Image size 2346x1568. Retinal fundus photograph.
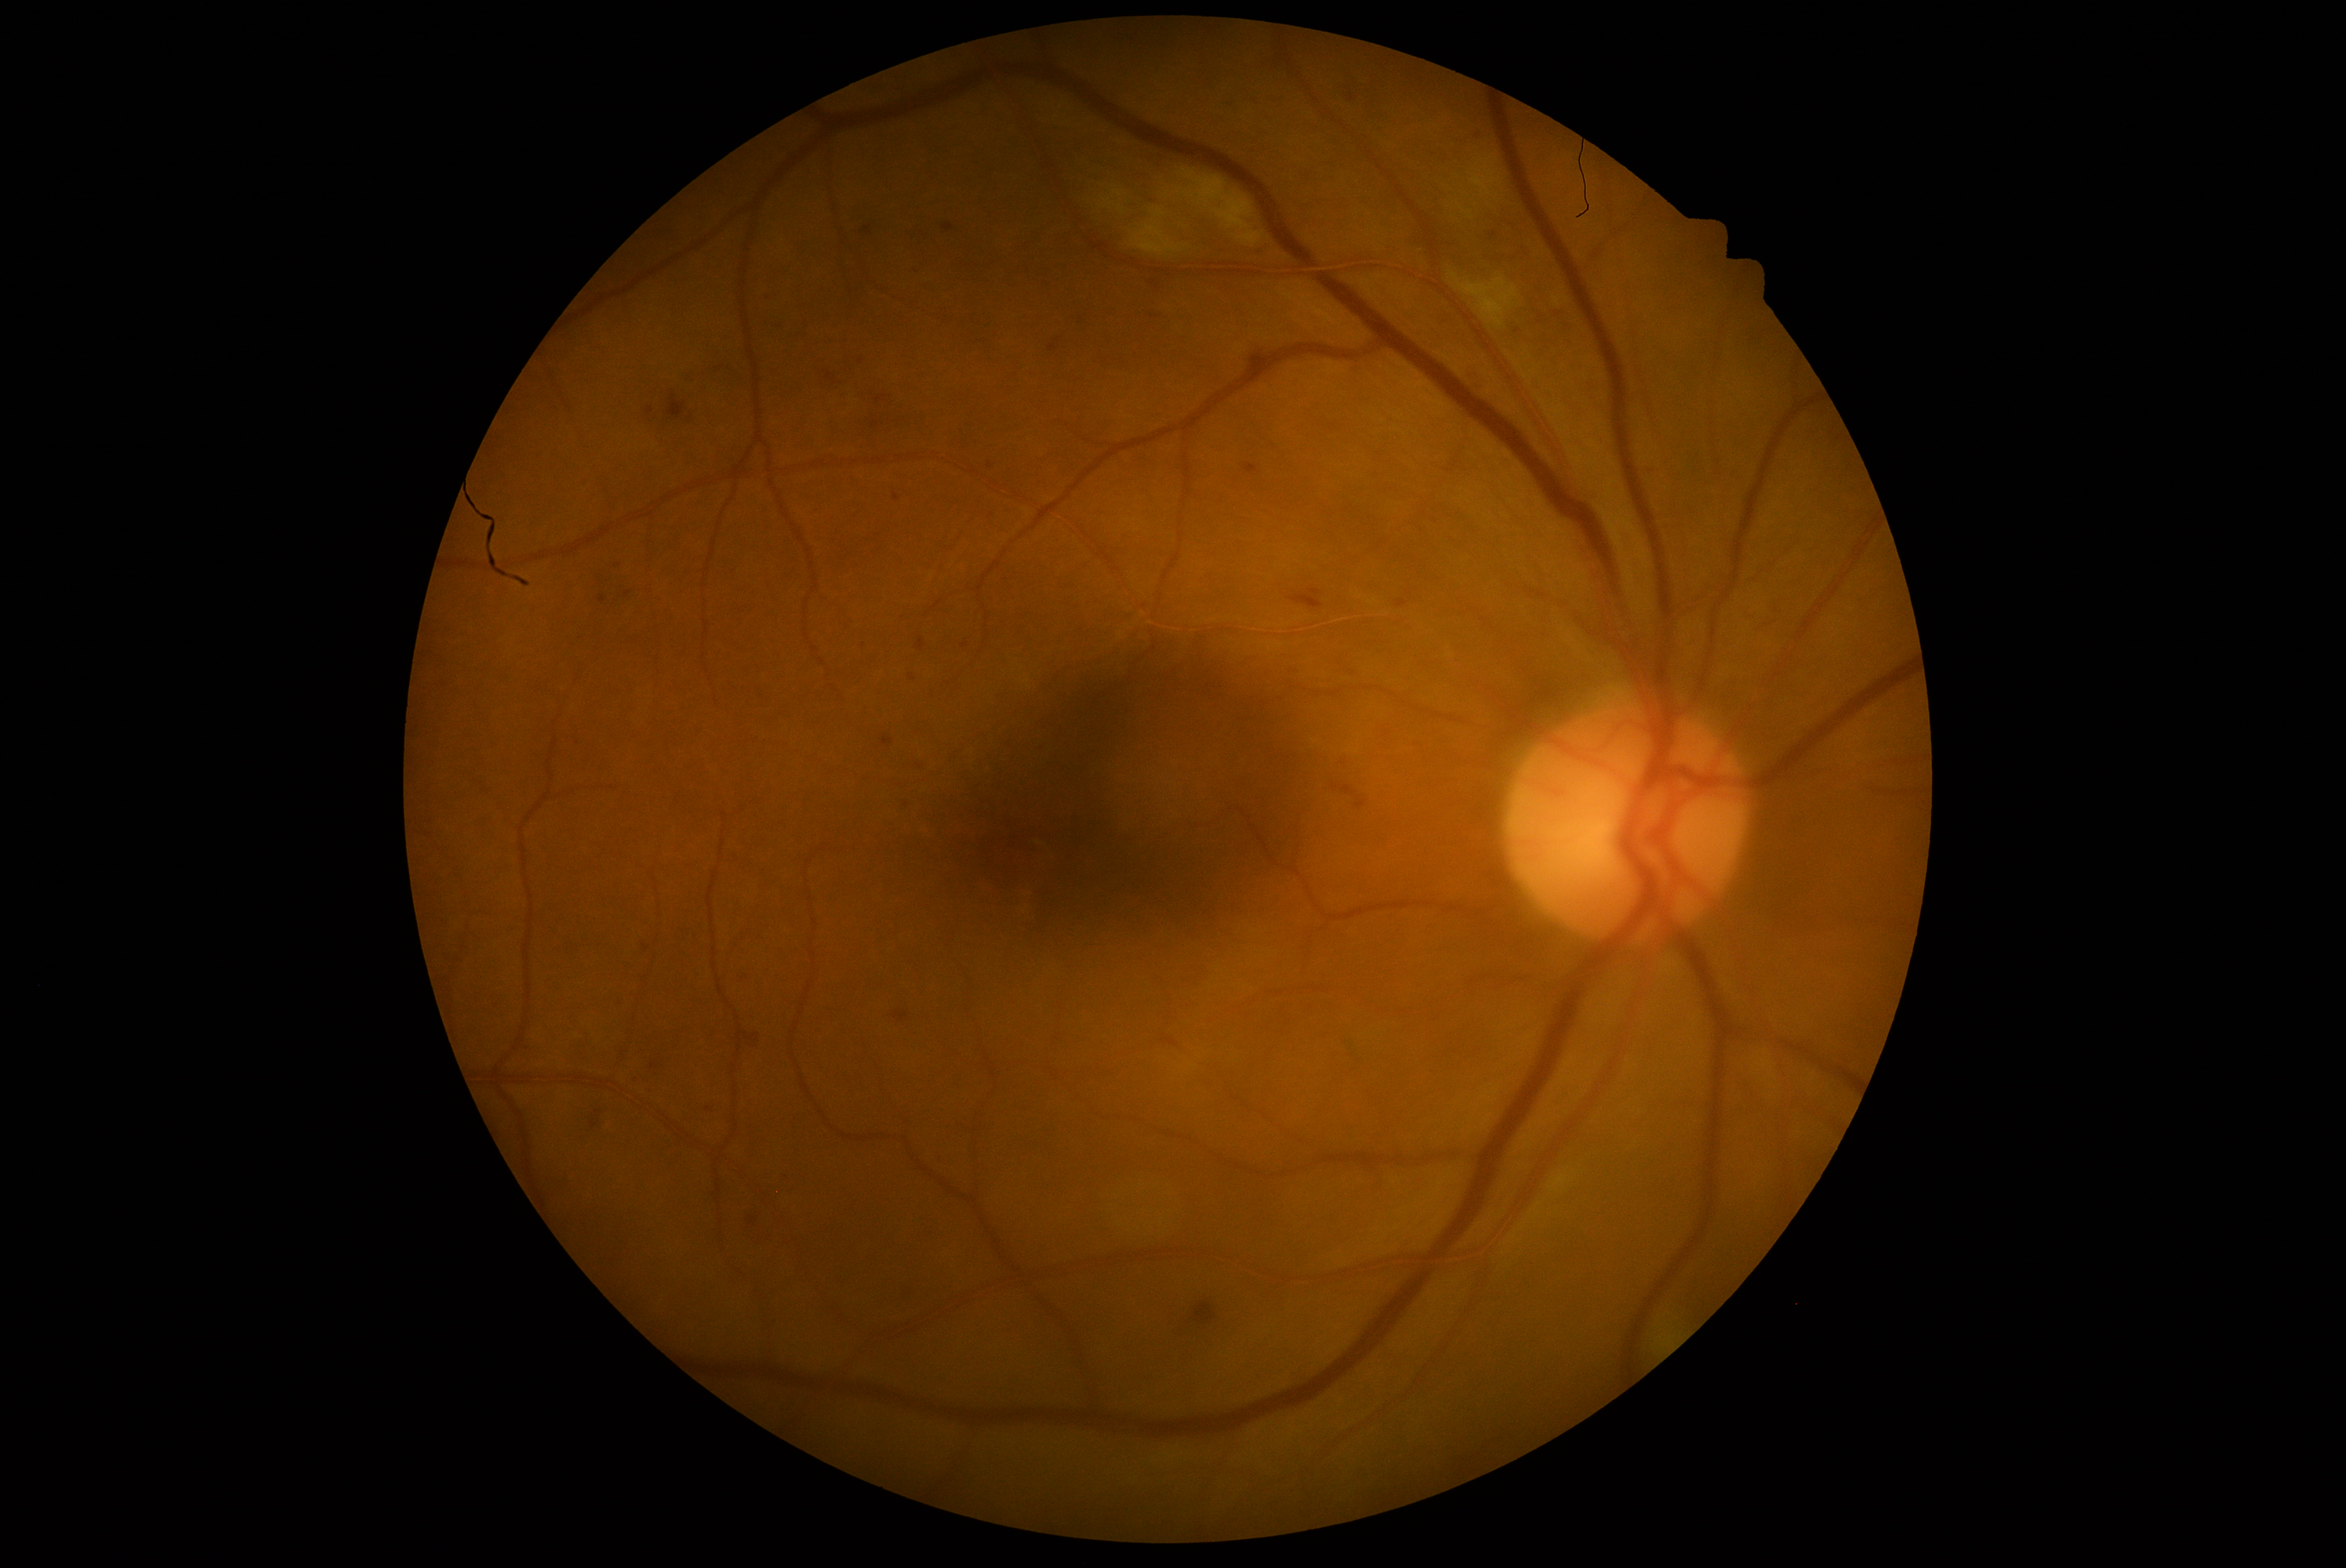
Diabetic retinopathy grade is 2 (moderate NPDR).